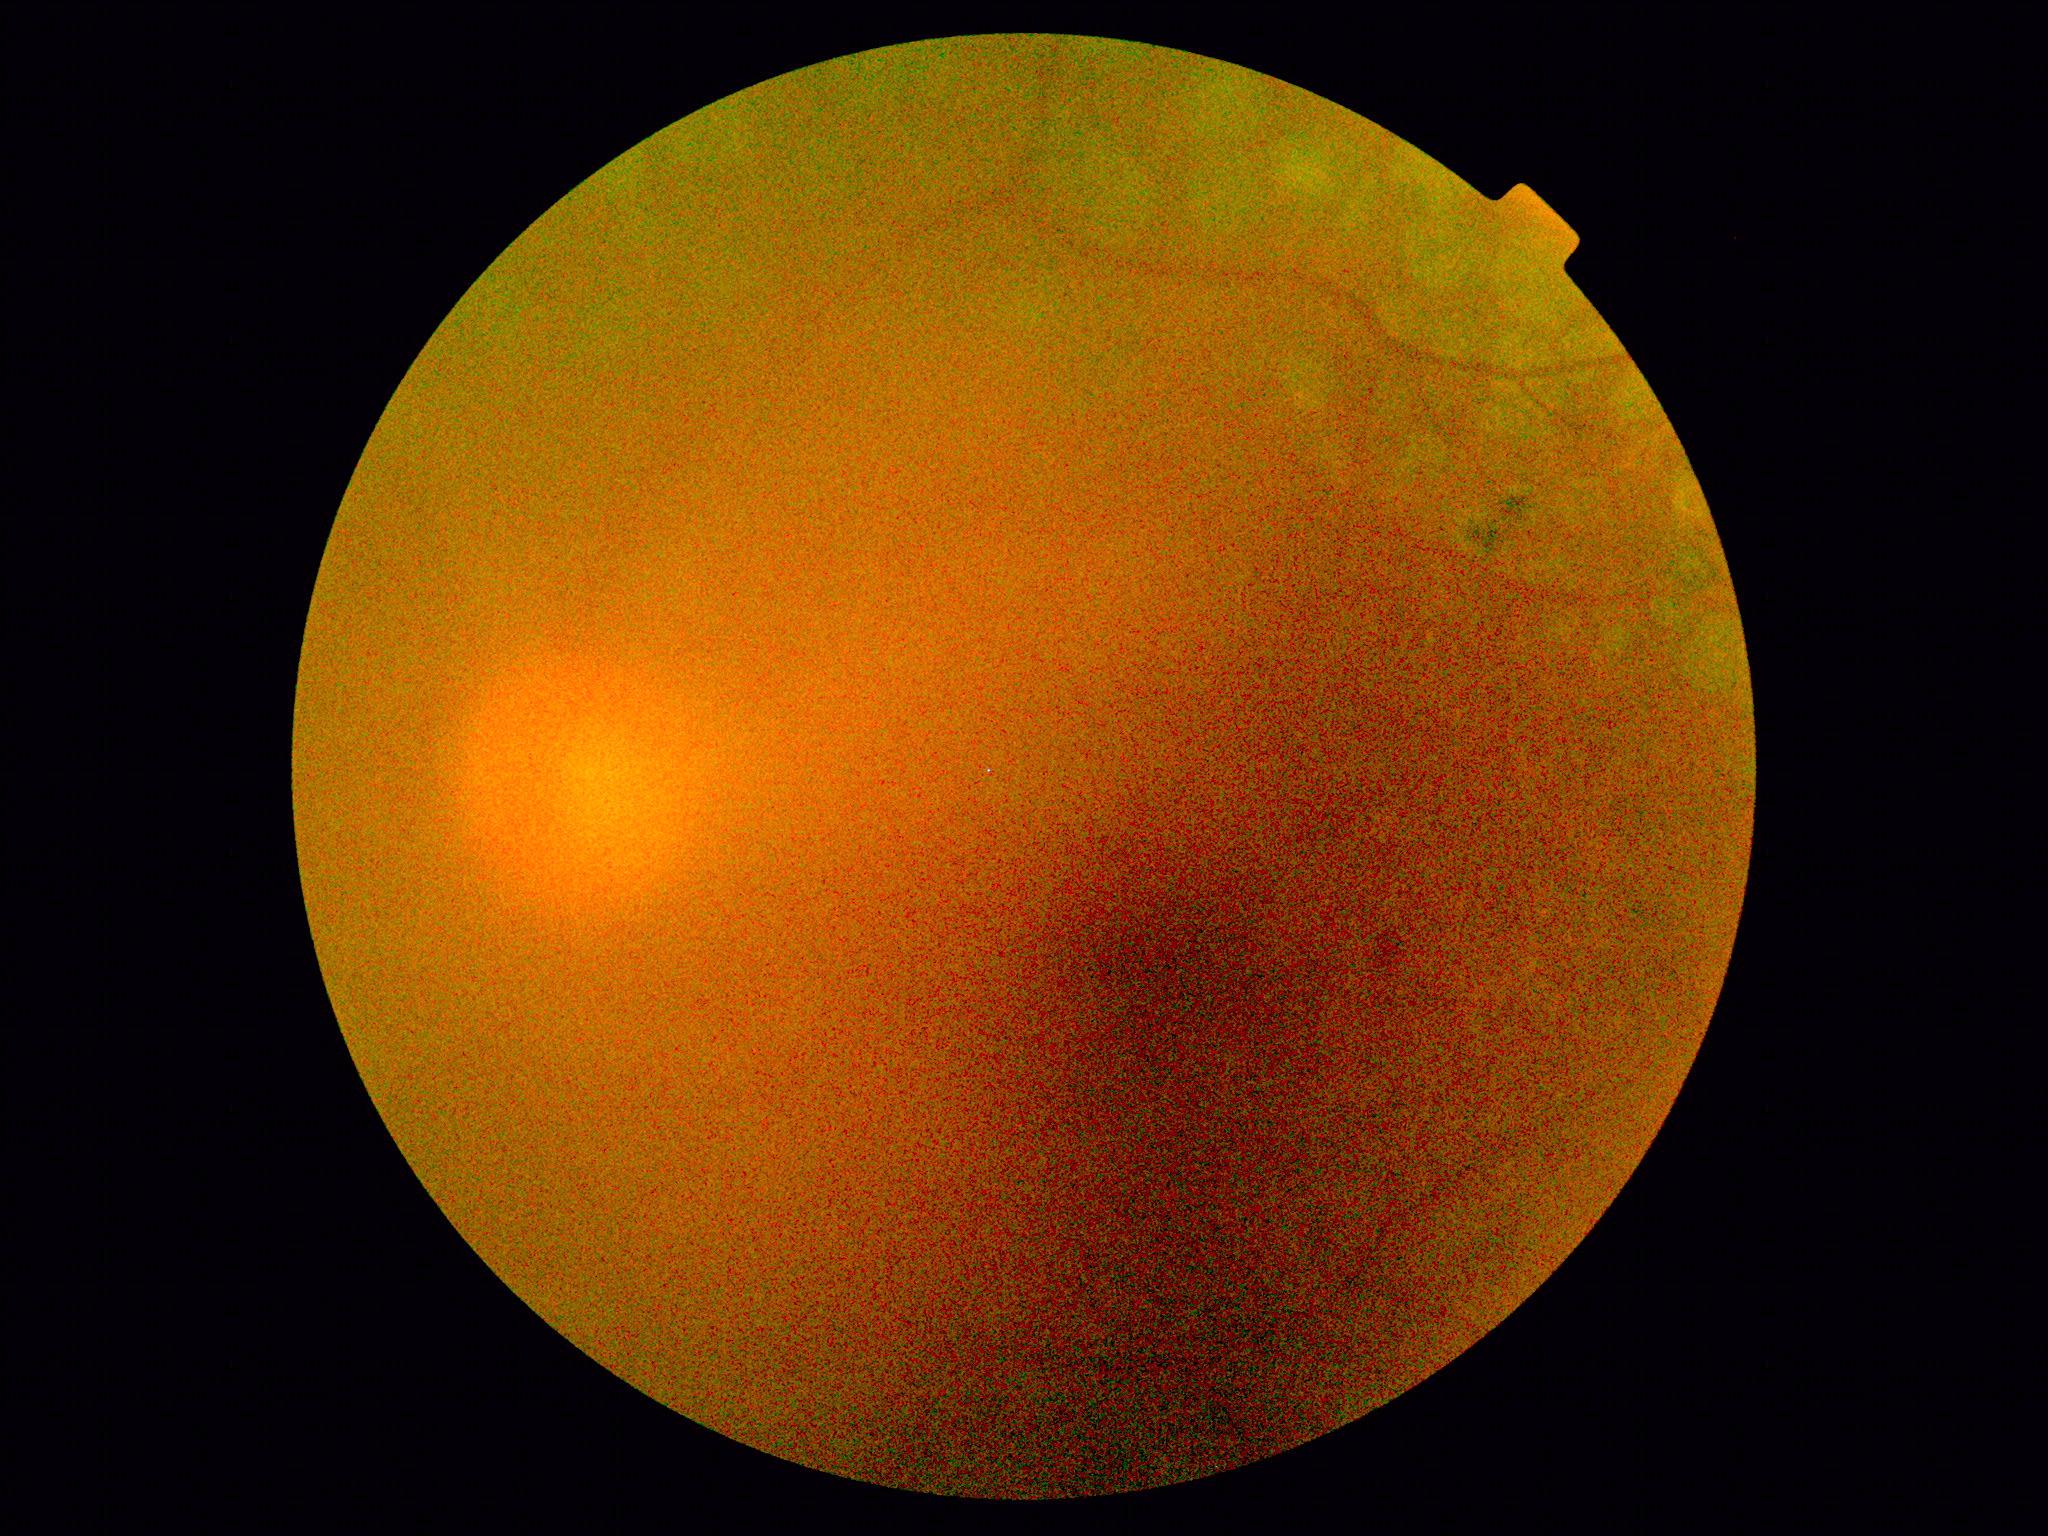
image quality@insufficient for DR assessment; DR grade@ungradable due to poor image quality.